Wide-field fundus photograph from neonatal ROP screening:
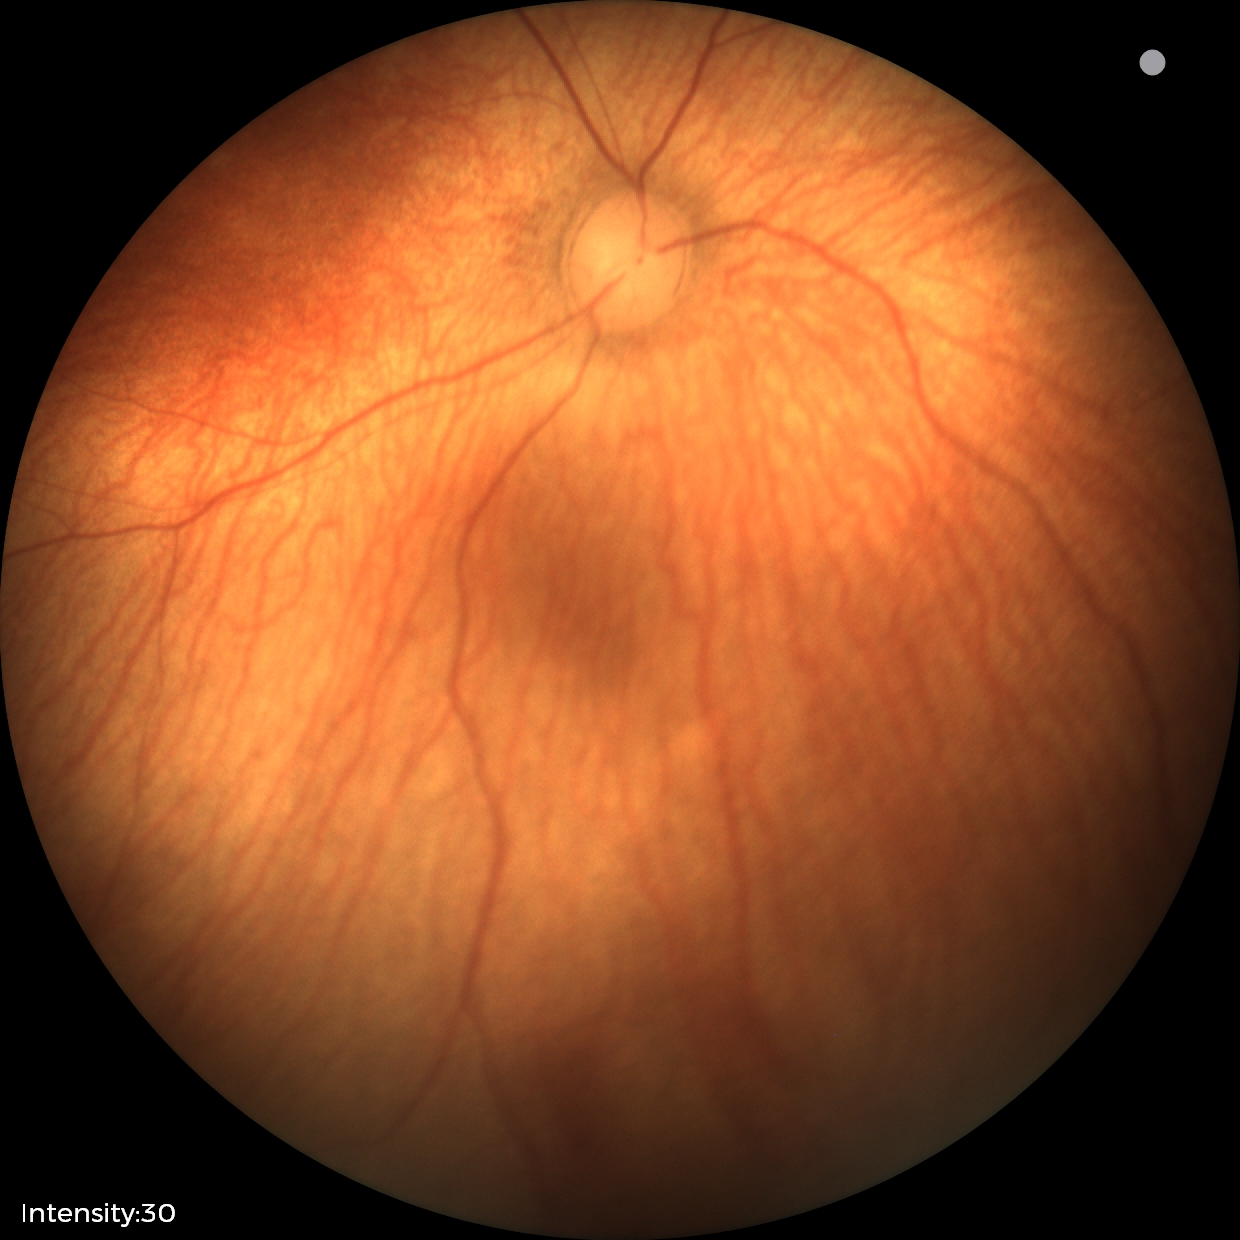
Normal screening examination.